Retinal fundus photograph.
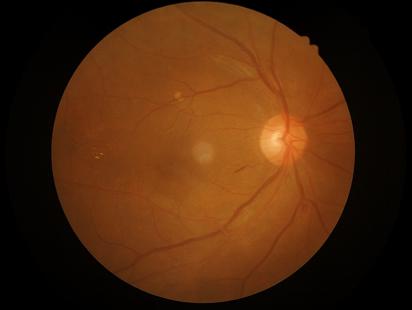
Quality grading: illumination/color: uniform, no color cast; overall: good and suitable for diagnostic use; contrast: wide intensity range, structures distinguishable; clarity: optic disc, vessels, and background in focus.